Image size 1932x1932:
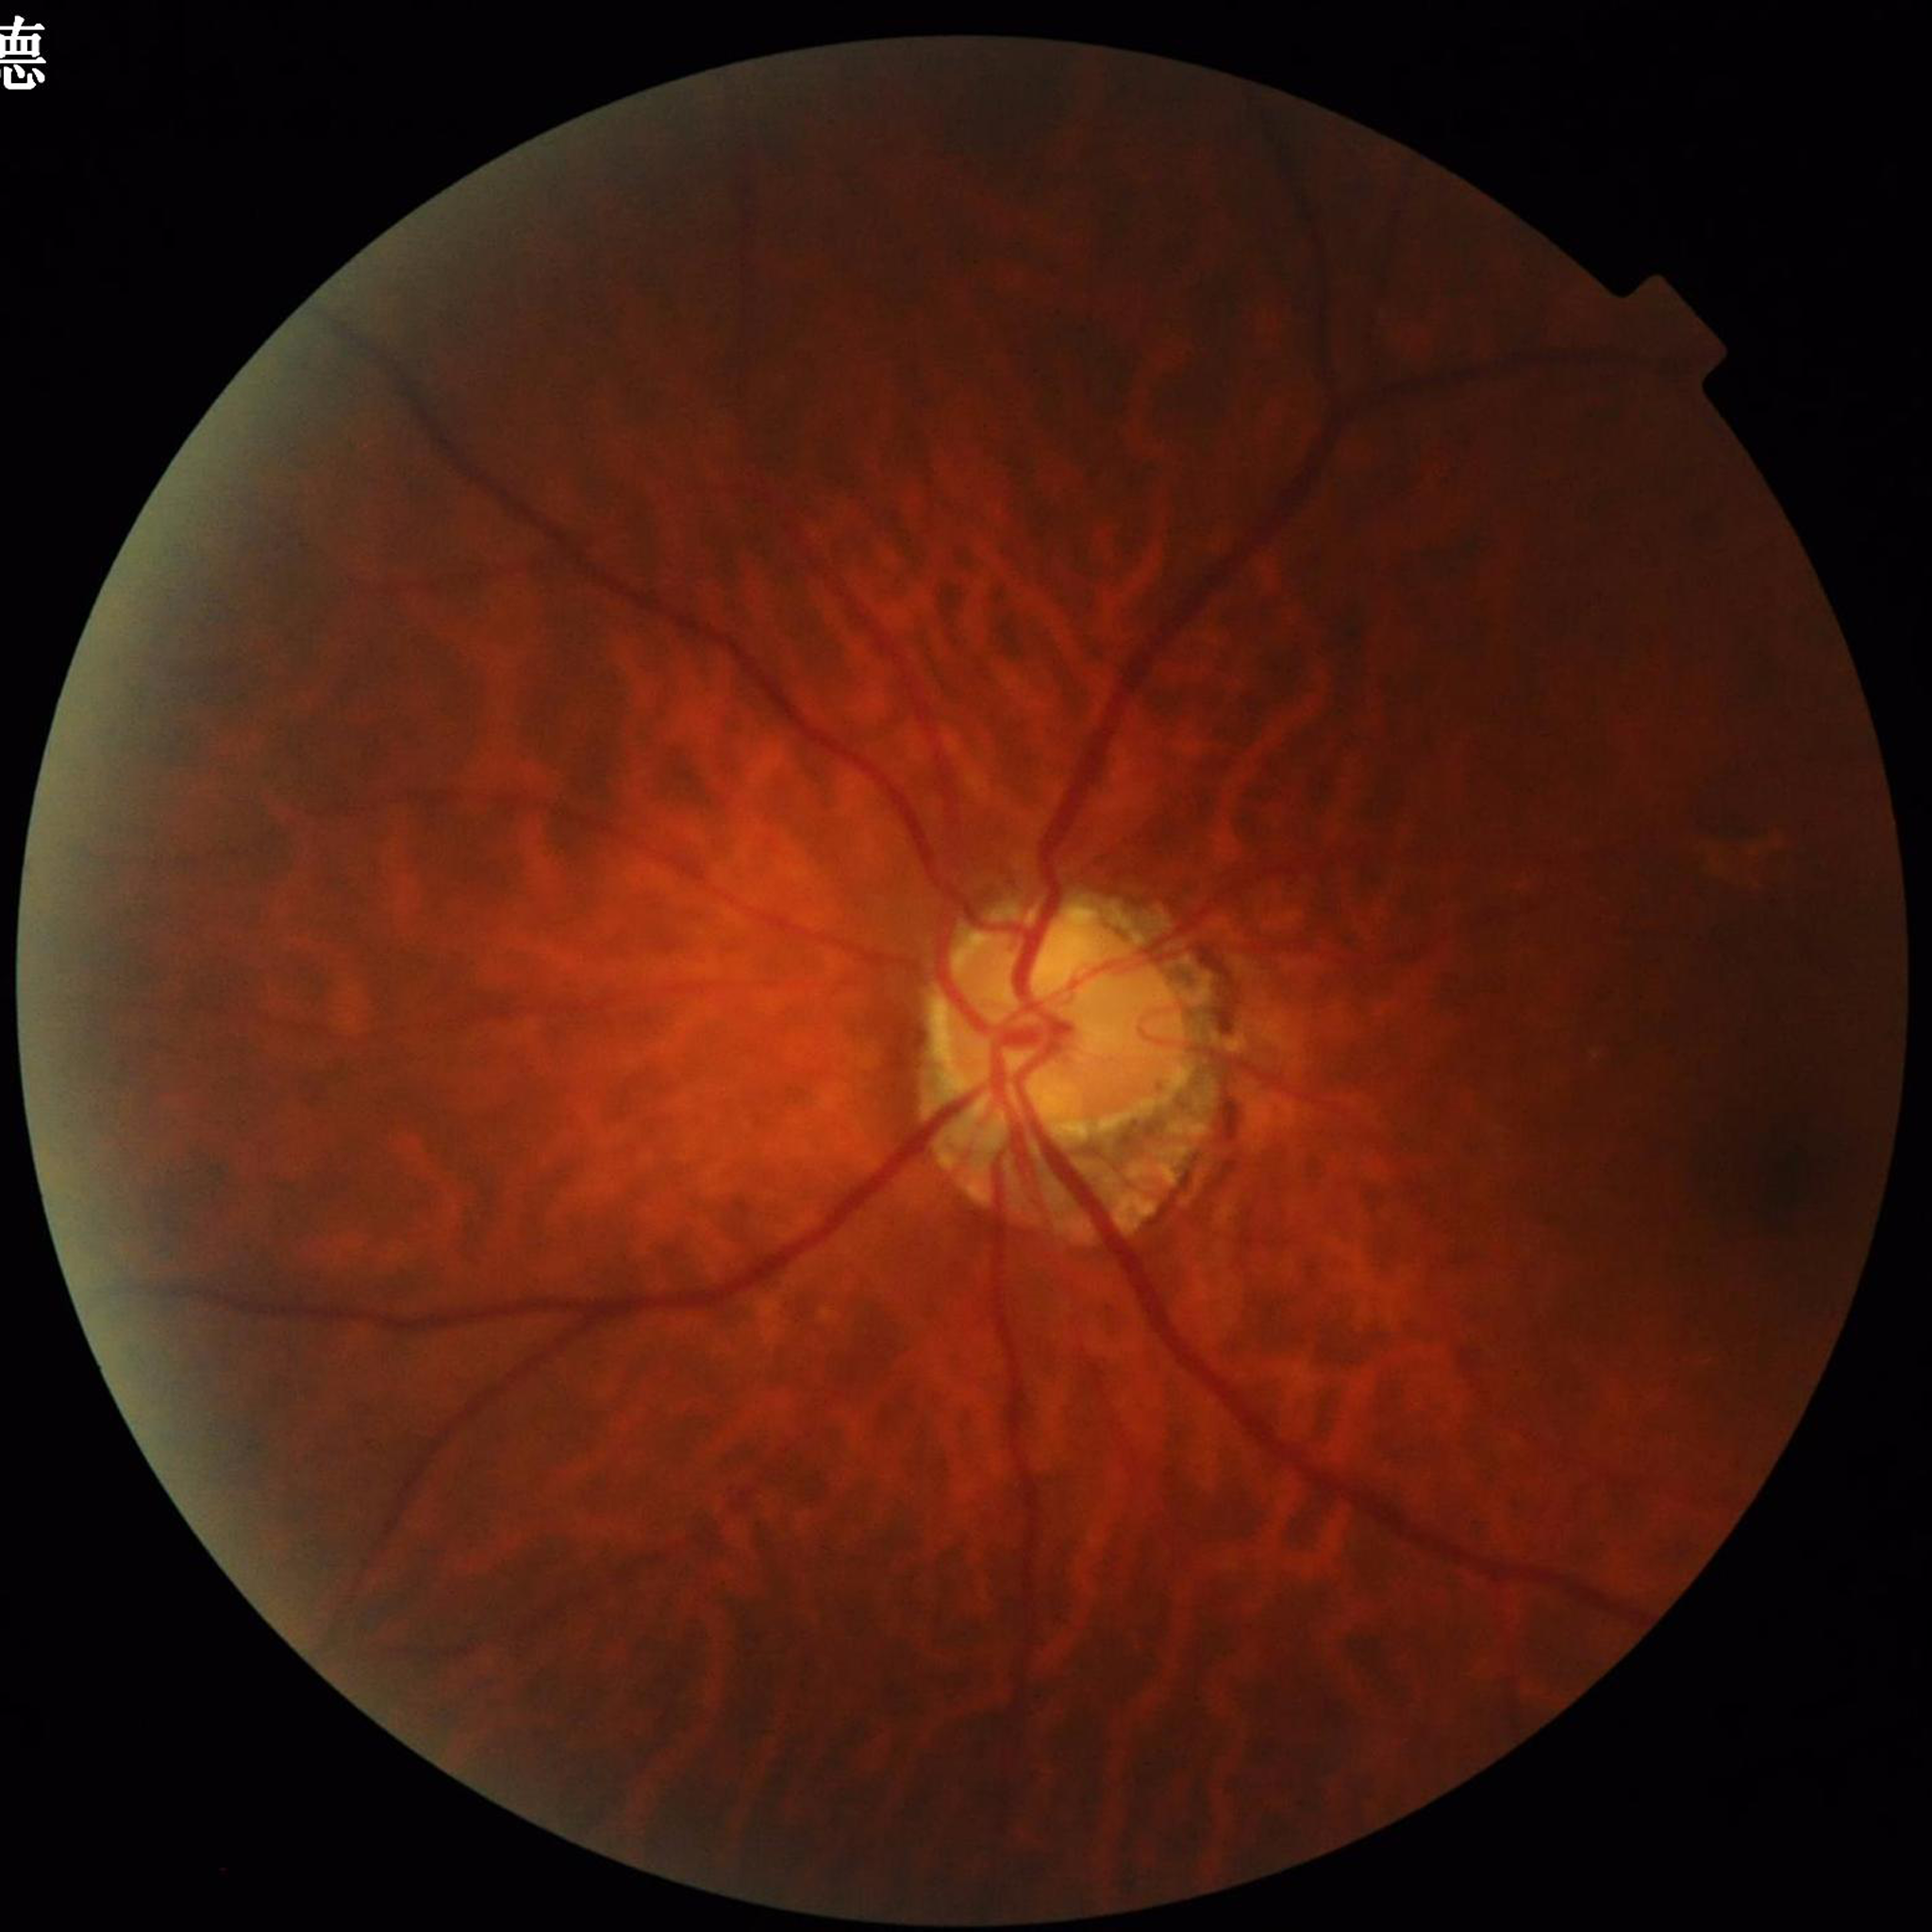

Photo quality: reduced — illumination/color distortion.
Eye affected by glaucoma.